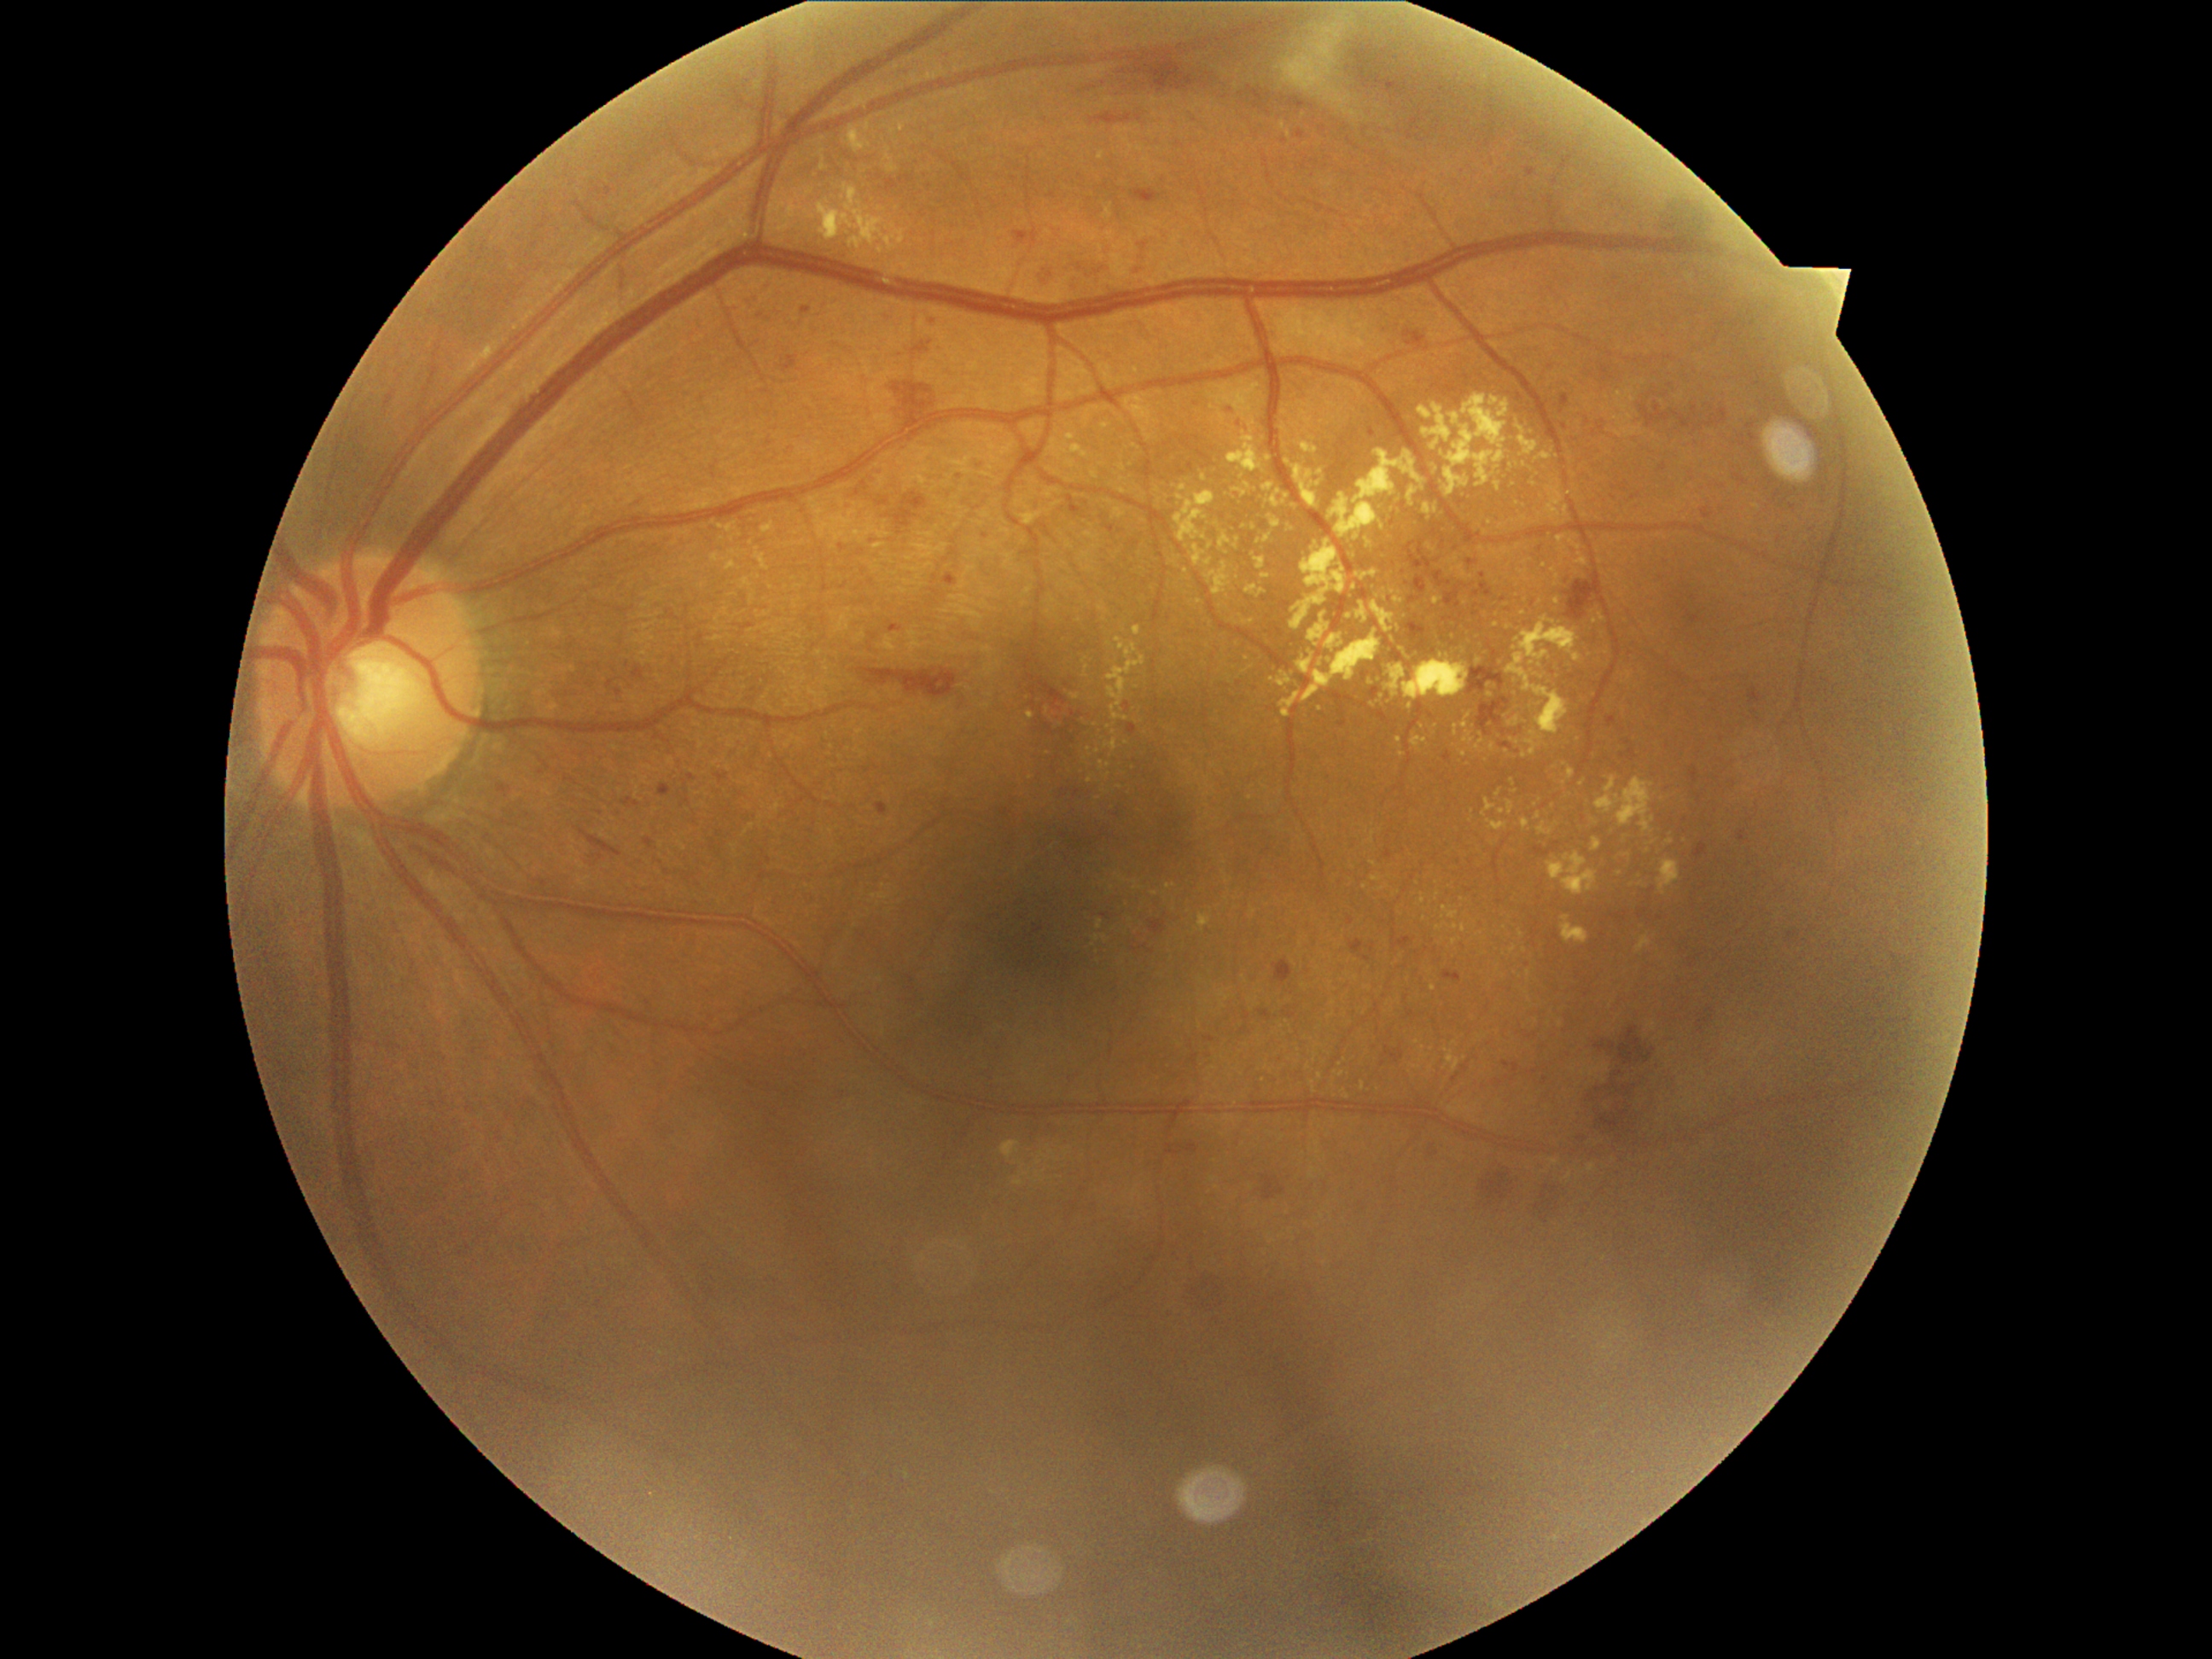
Retinopathy grade is 2 (moderate NPDR) — more than just microaneurysms but less than severe NPDR
Selected lesions:
hard exudates (more not shown): x1=1208, y1=542, x2=1214, y2=550 | x1=1066, y1=434, x2=1076, y2=441 | x1=1291, y1=540, x2=1348, y2=631 | x1=1371, y1=603, x2=1395, y2=634 | x1=1325, y1=636, x2=1344, y2=653 | x1=1103, y1=740, x2=1119, y2=752 | x1=1411, y1=735, x2=1428, y2=748 | x1=1394, y1=622, x2=1404, y2=631 | x1=1510, y1=716, x2=1520, y2=726
Smaller hard exudates around pt(1108, 728) | pt(1486, 532) | pt(1288, 496) | pt(1778, 751) | pt(1539, 704) | pt(1556, 603) | pt(1269, 459) | pt(1383, 527) | pt(1320, 473) | pt(1417, 1042)